Color fundus photograph; 45-degree field of view.
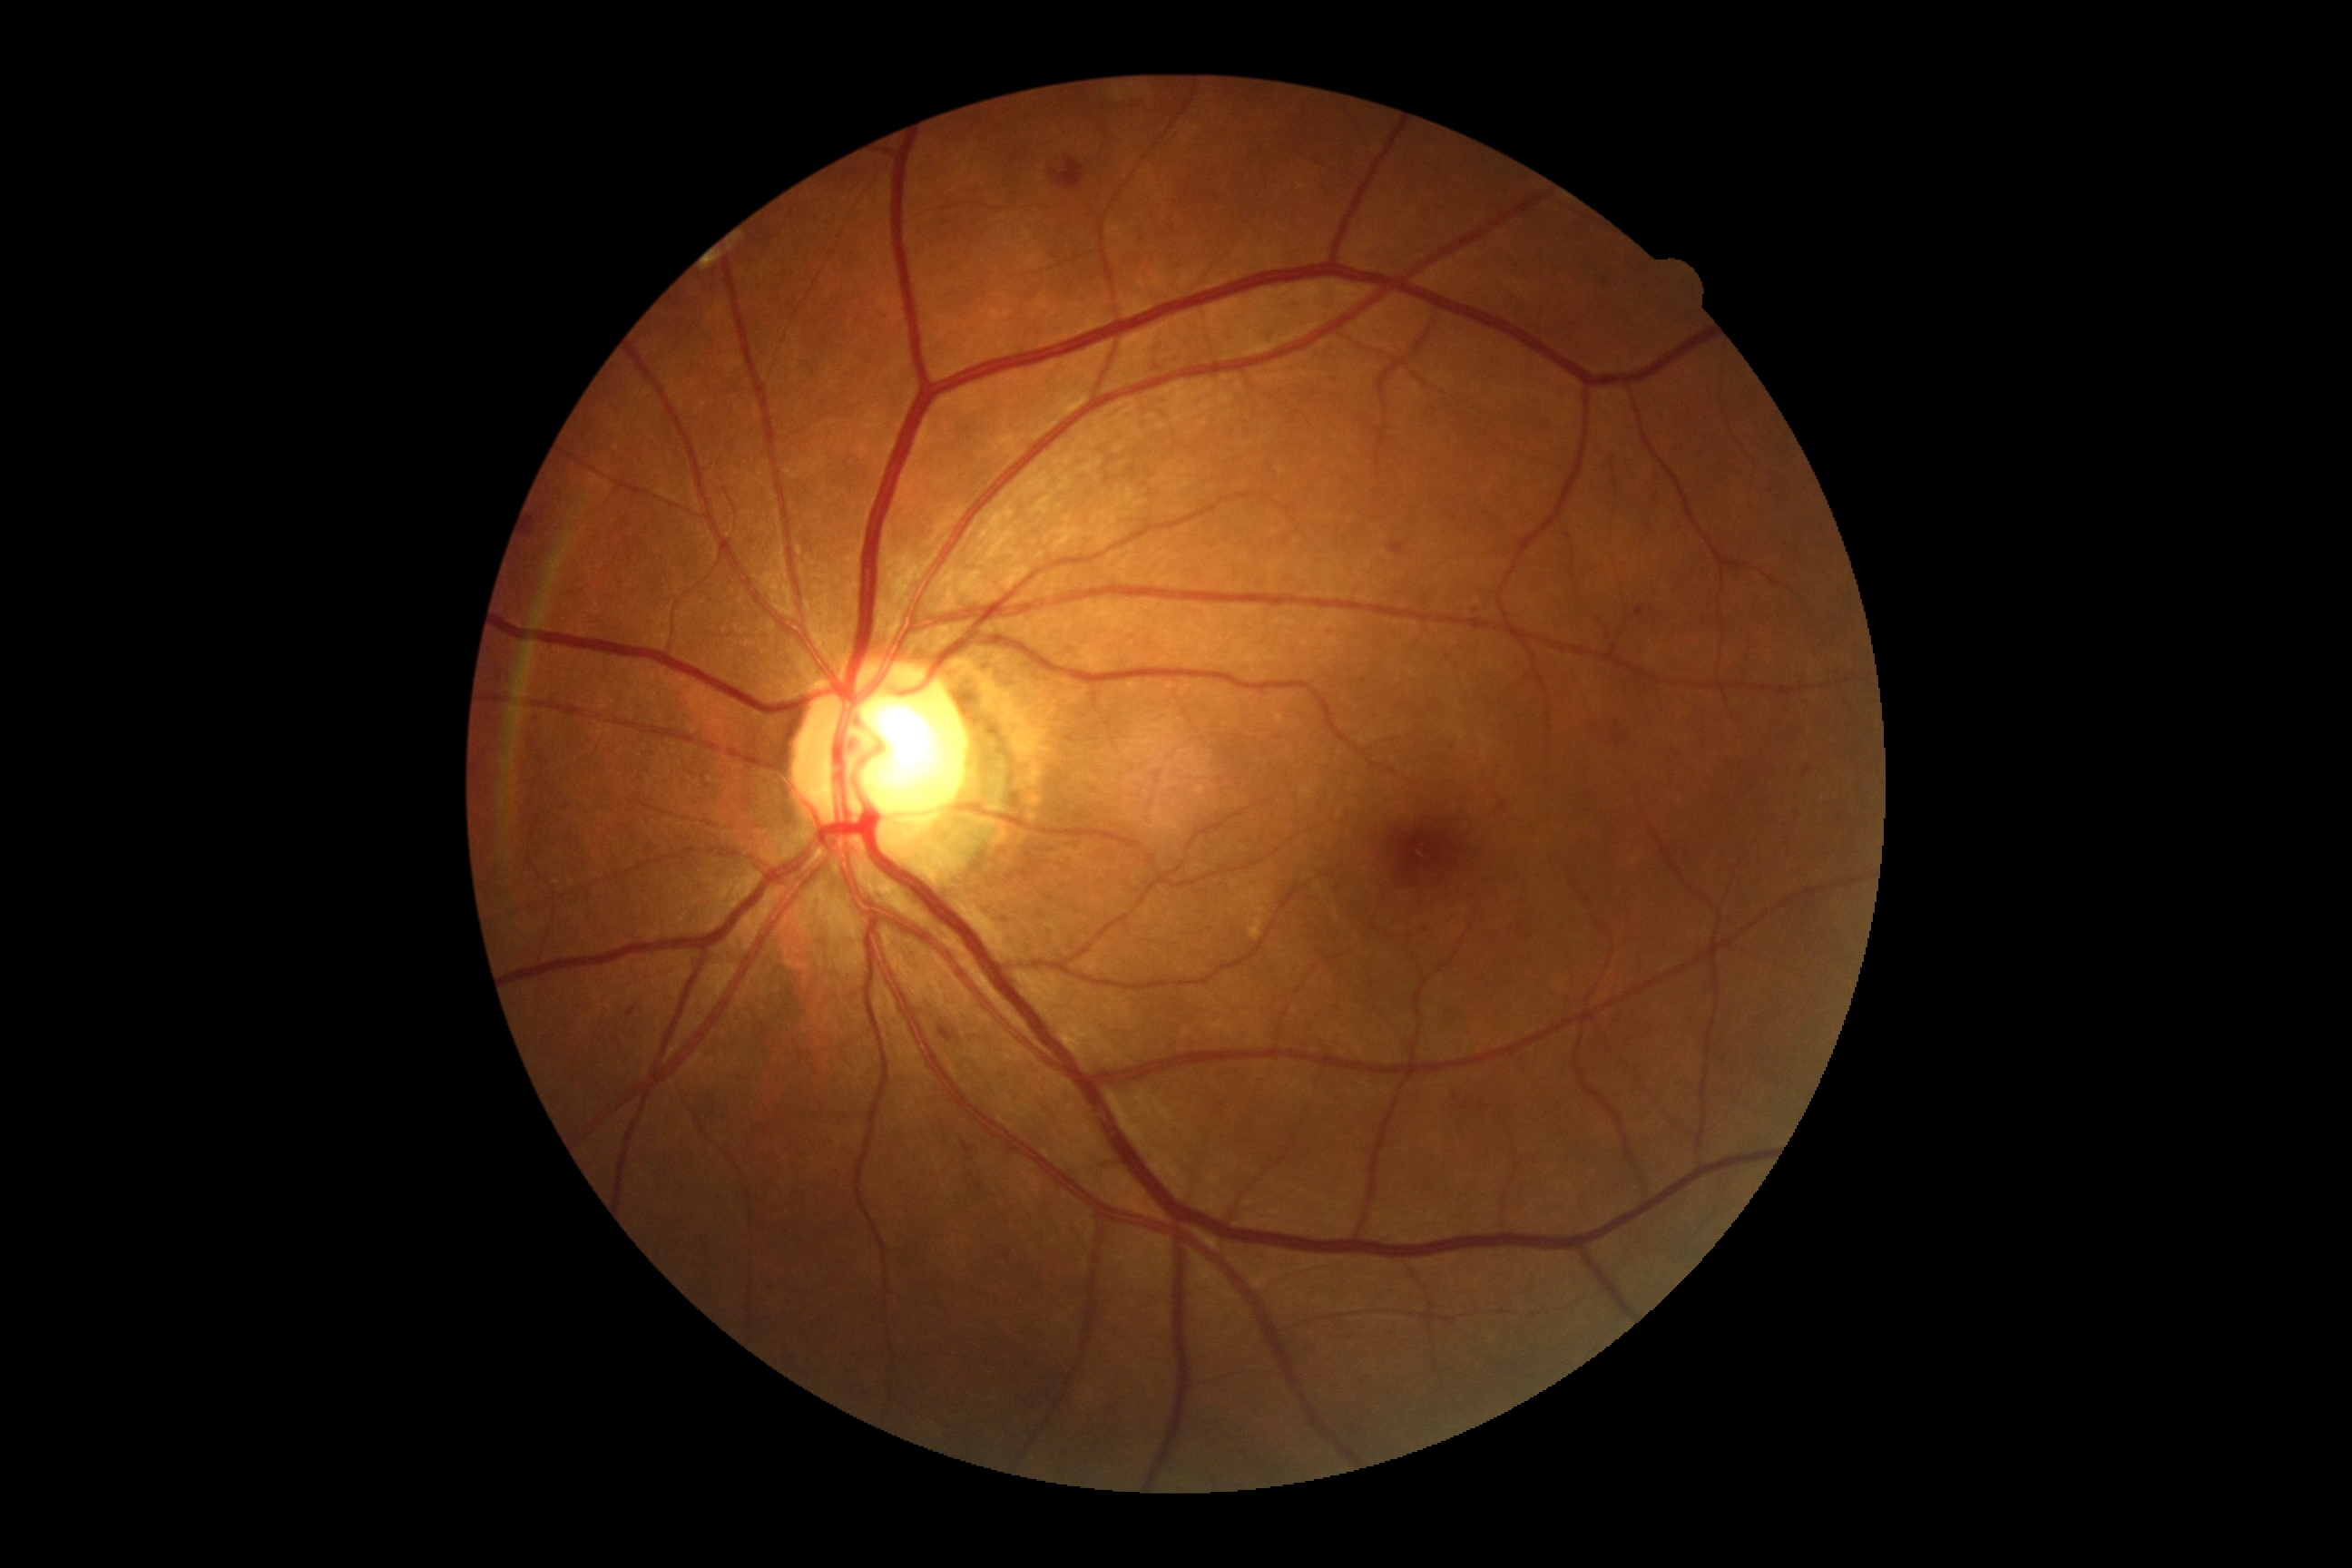
Diabetic retinopathy grade: 2 (moderate NPDR).